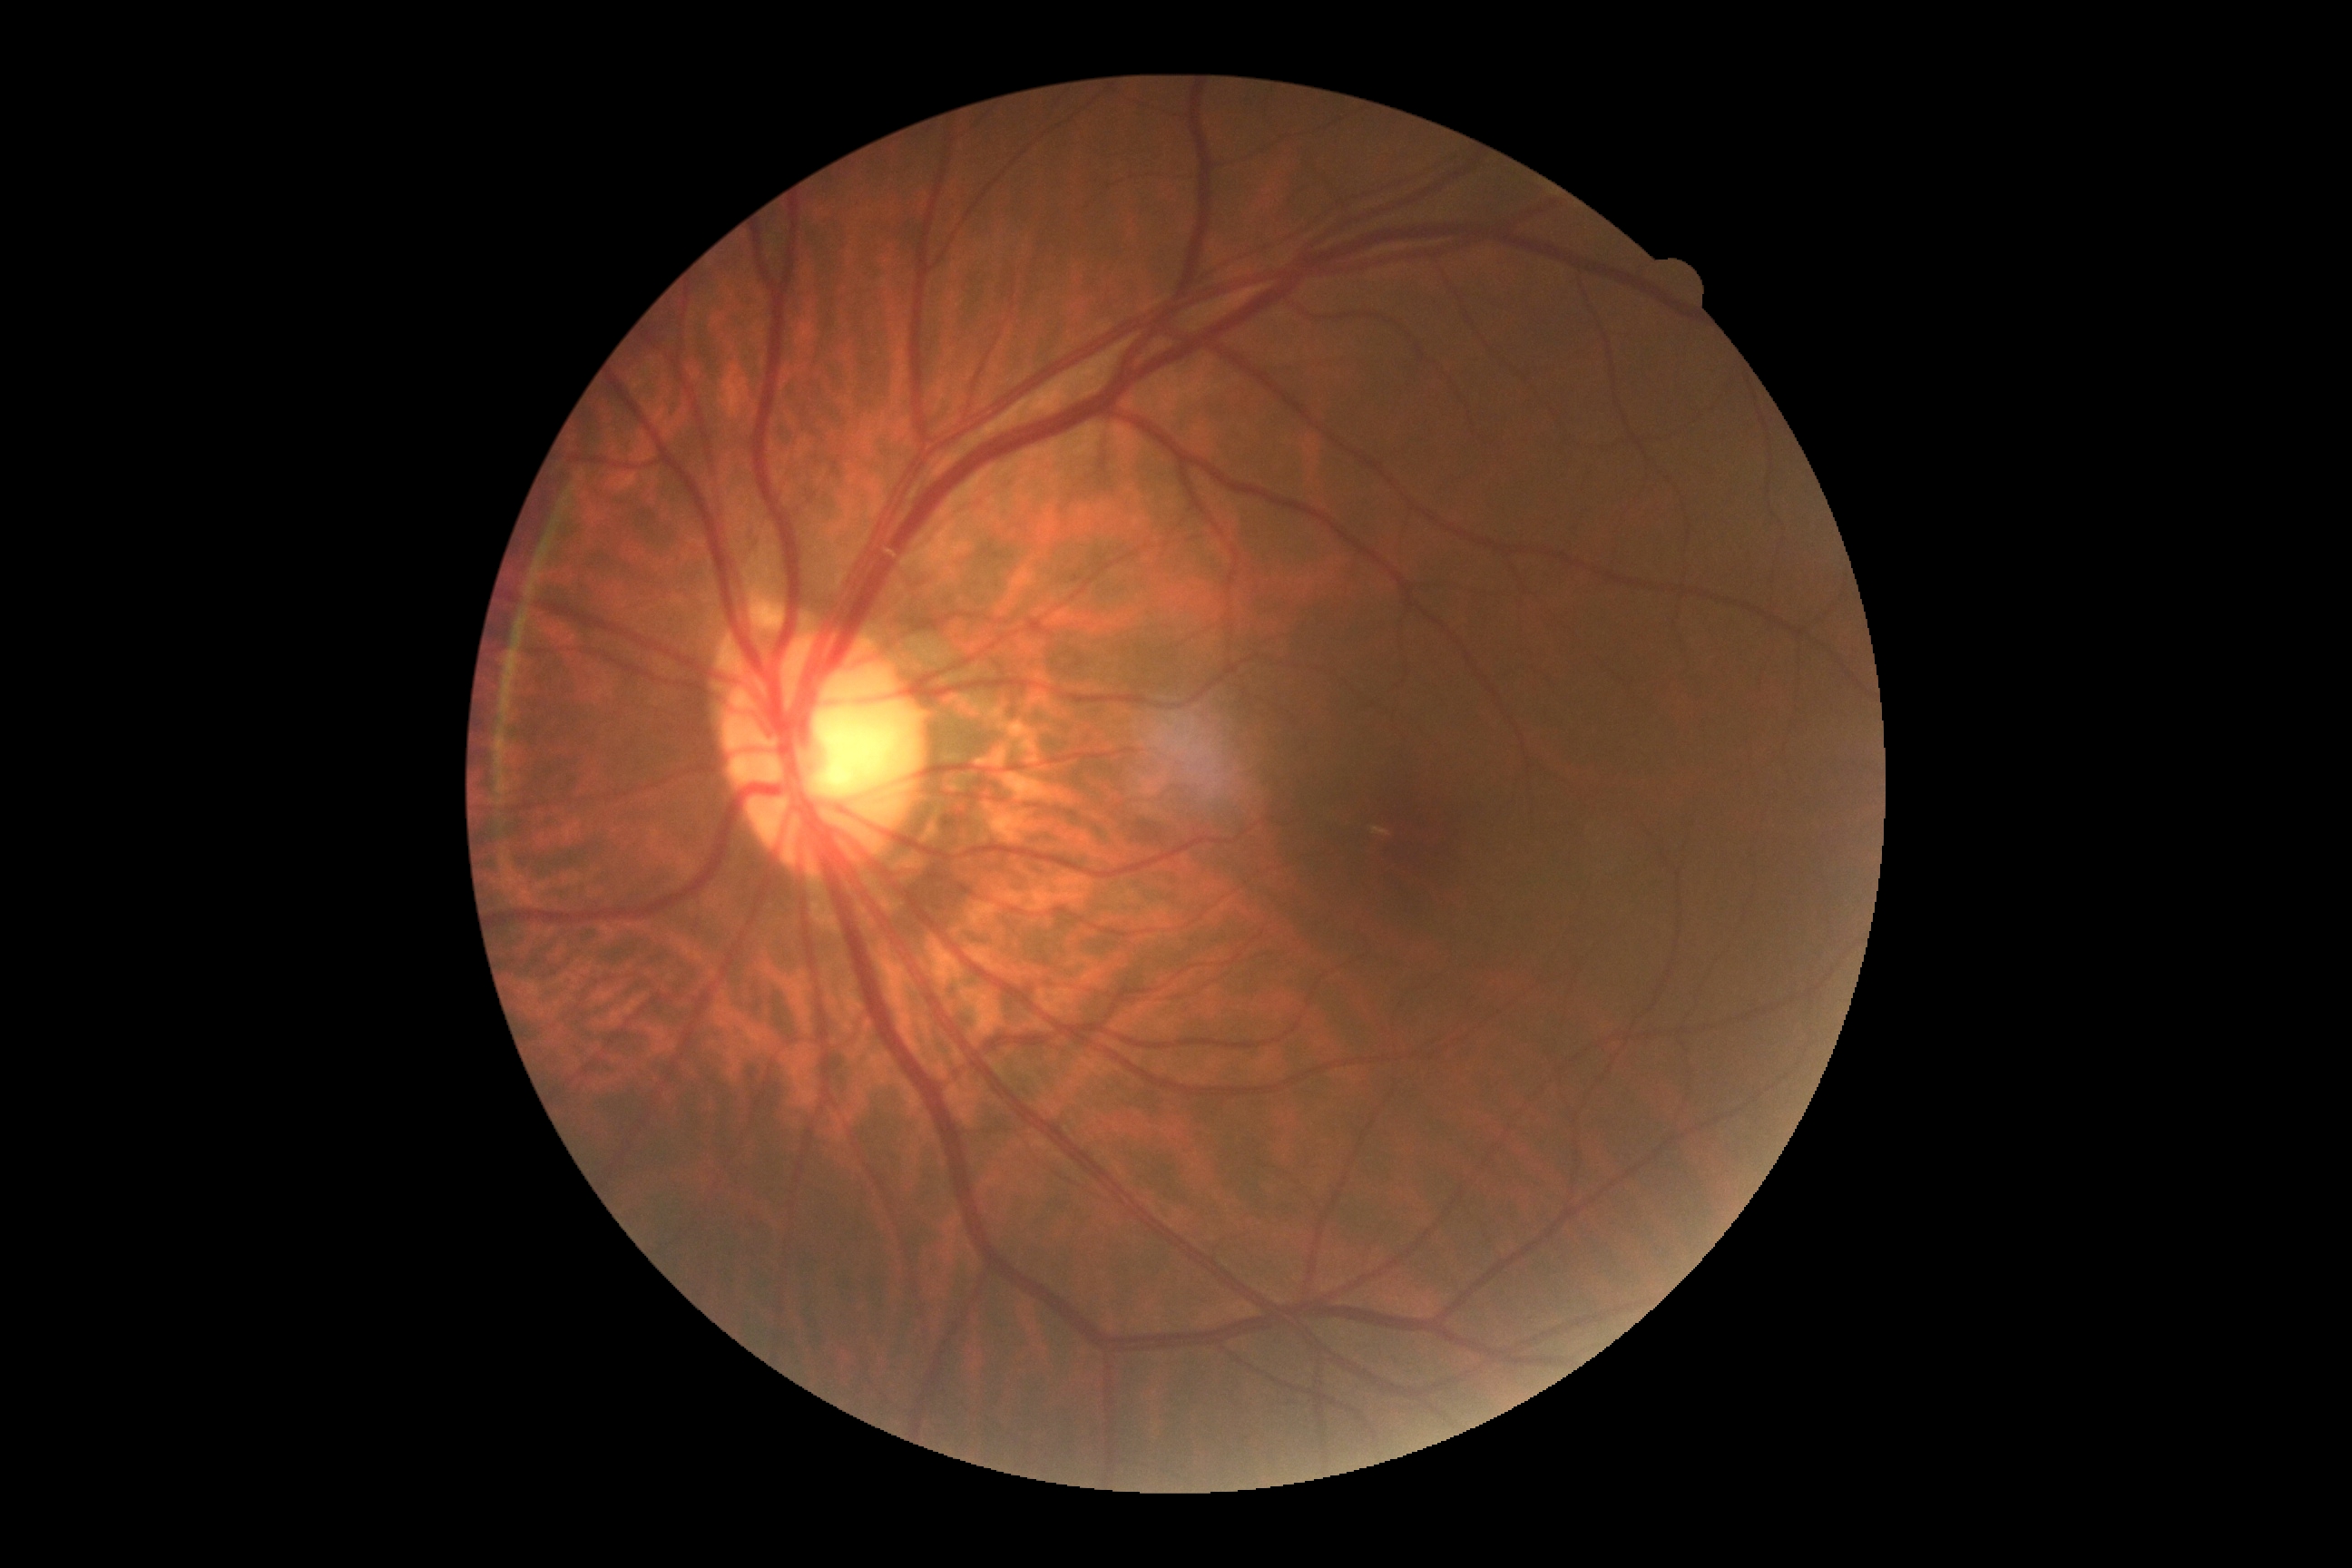

Diabetic retinopathy severity is grade 0 — no visible signs of diabetic retinopathy.